Image size 1240x1240. Acquired on the Phoenix ICON. Phoenix ICON wide-field infant fundus image: 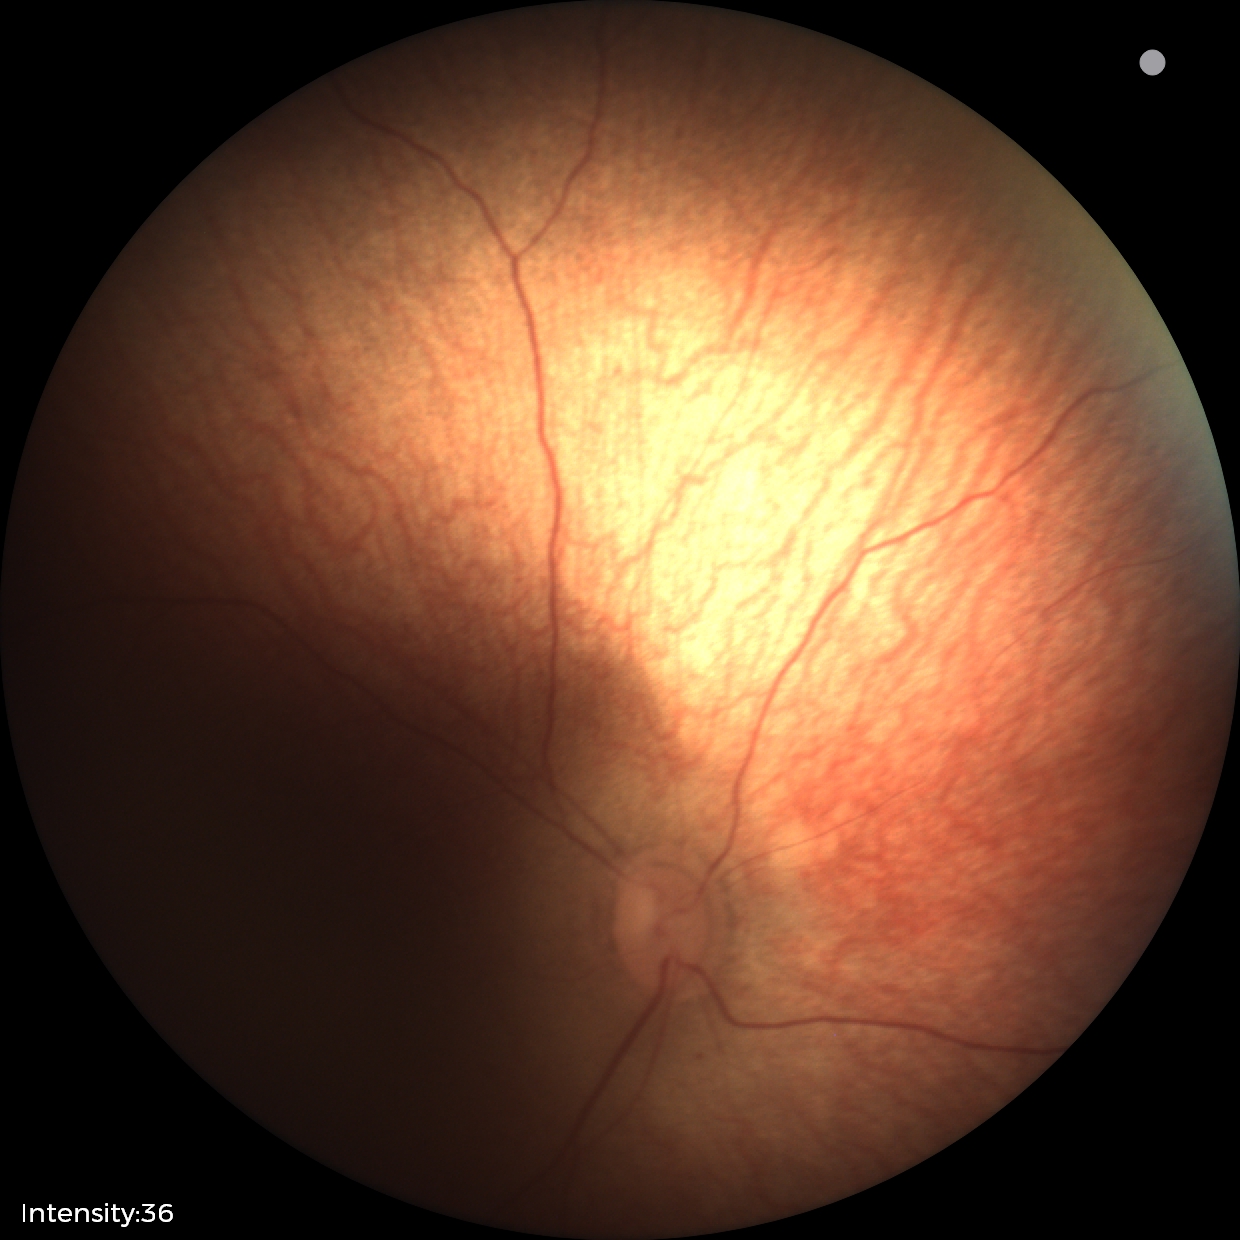
Q: What is the screening diagnosis?
A: normal fundus examination